Captured without pupil dilation. IOP by non-contact tonometry: 14 mmHg. 67-year-old patient — 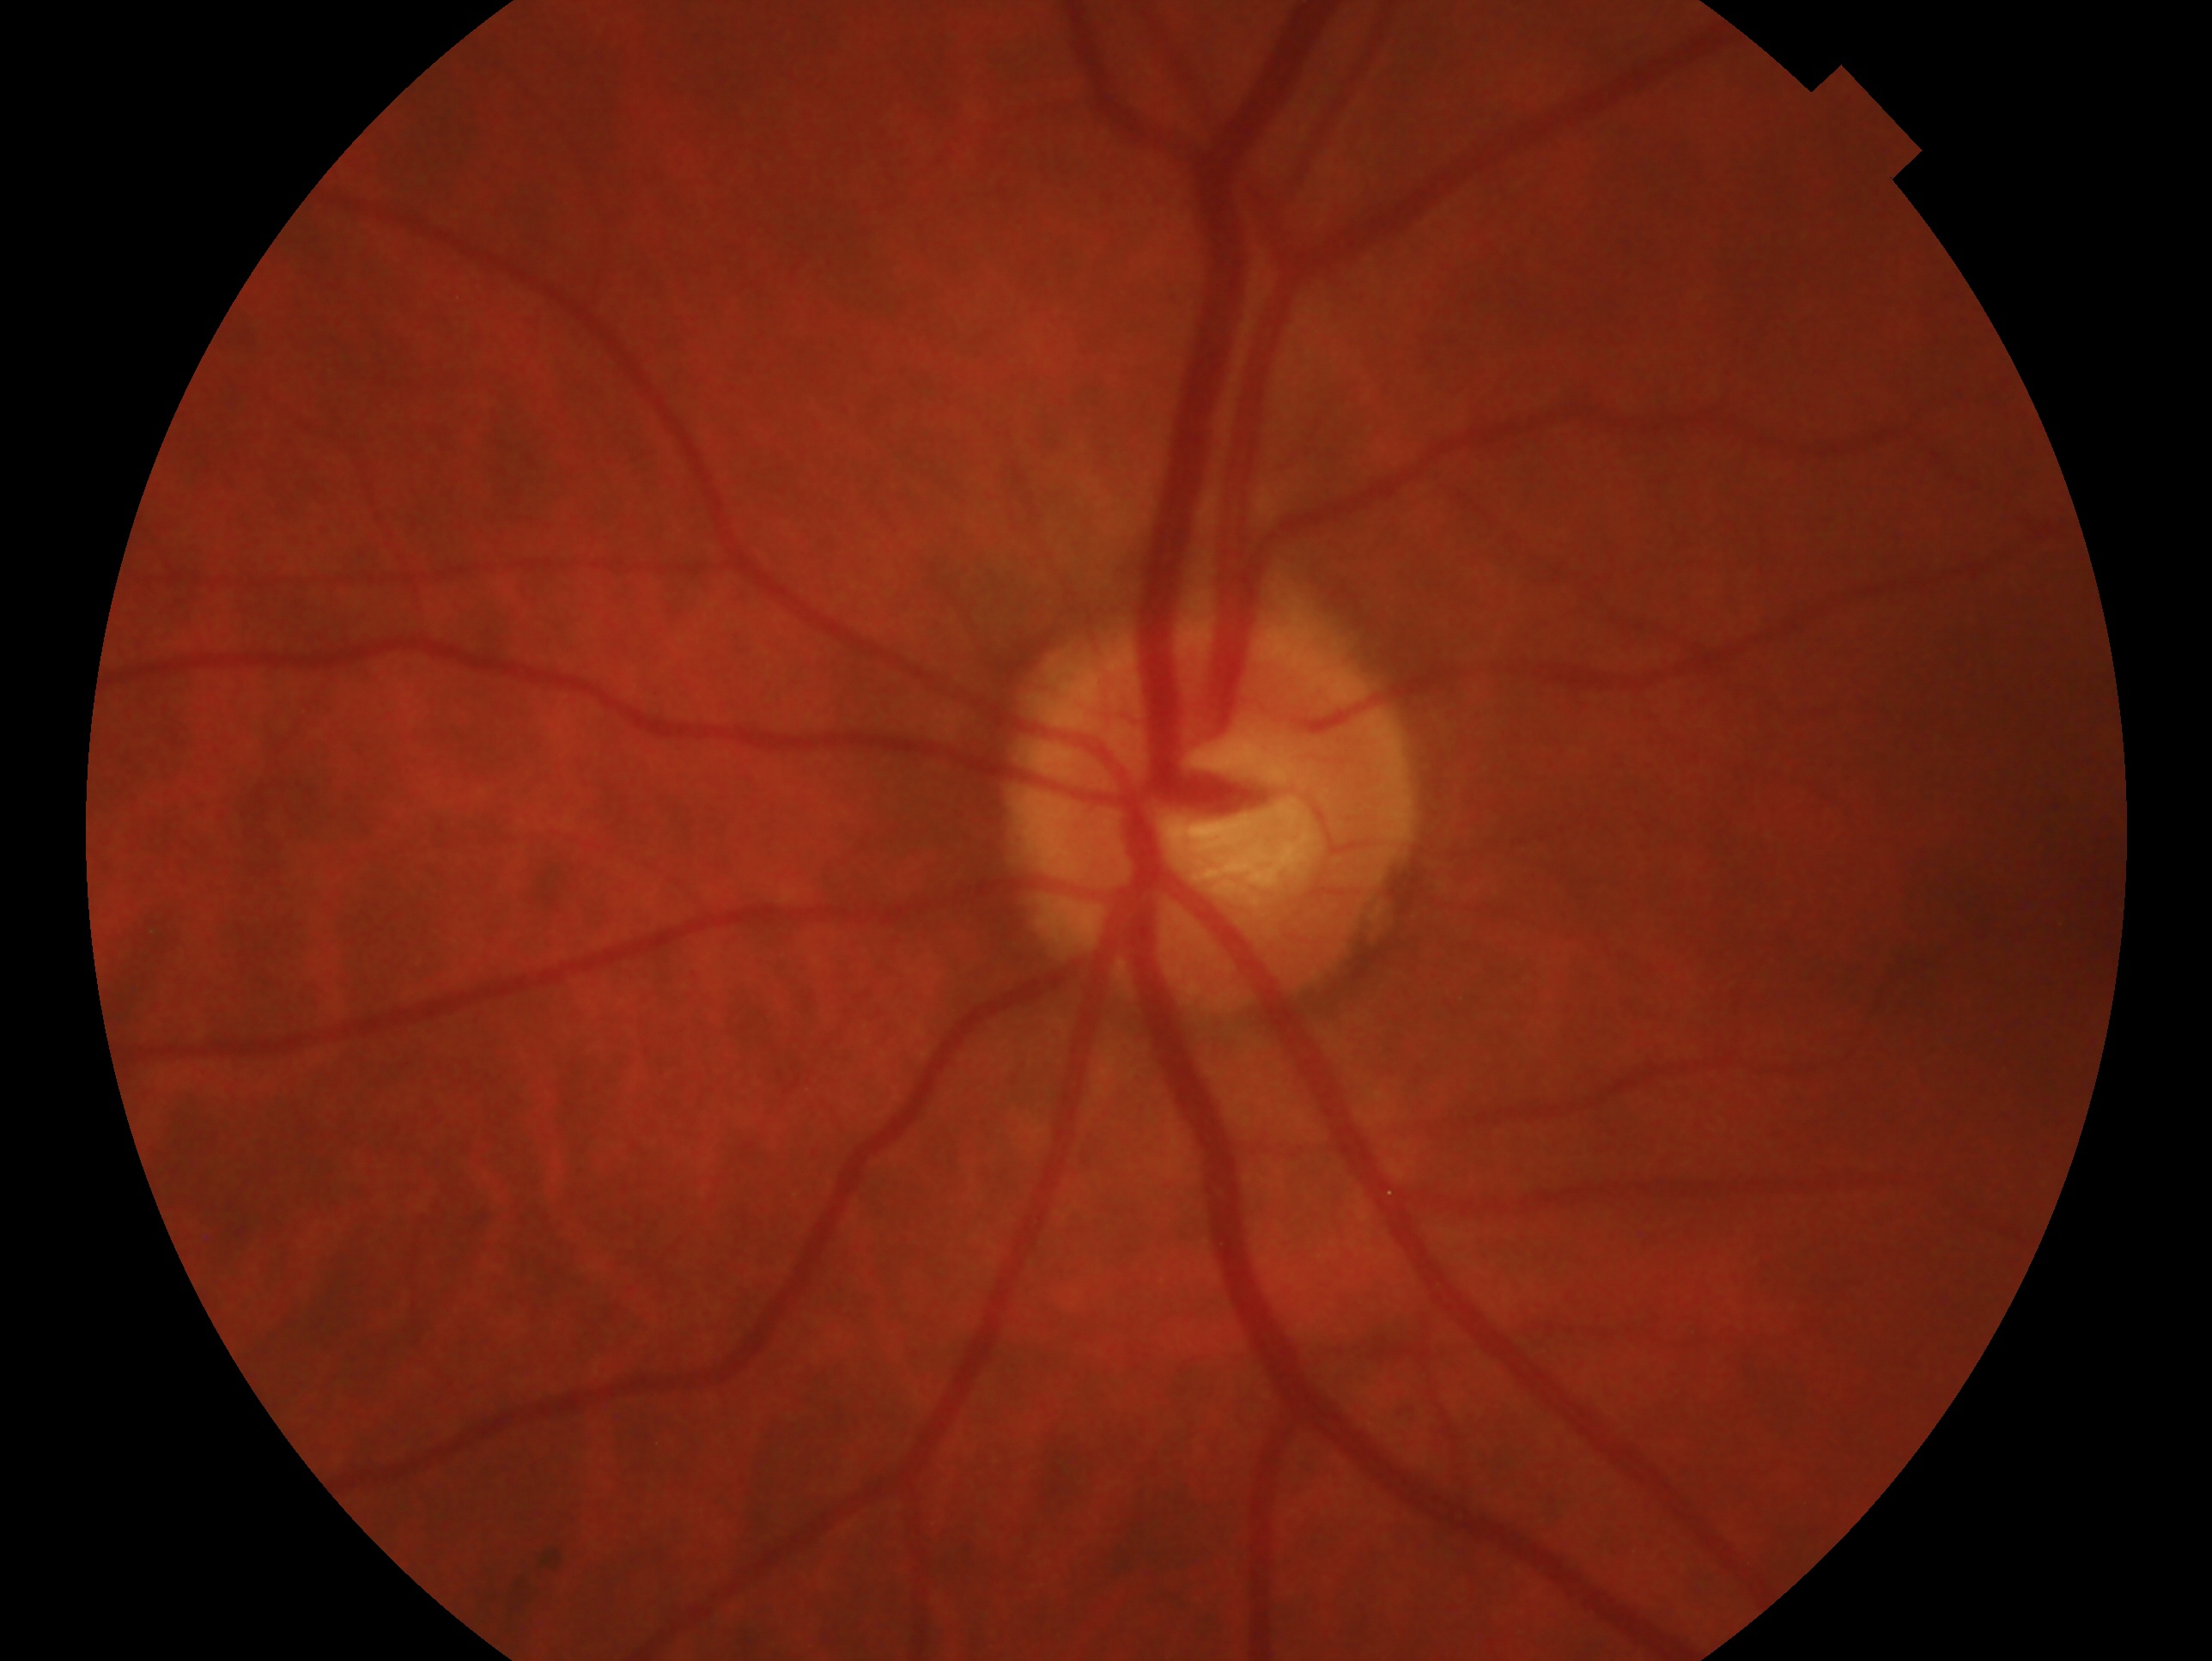
Assessment — no signs of glaucoma. The image shows the oculus sinister.